Pediatric wide-field fundus photograph:
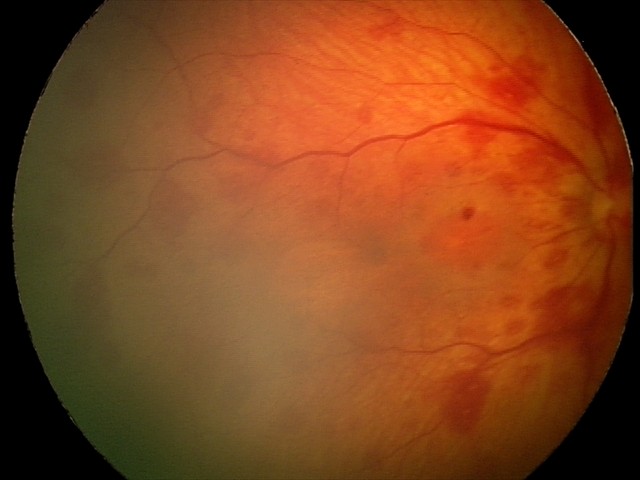

From an examination with diagnosis of retinal hemorrhages.